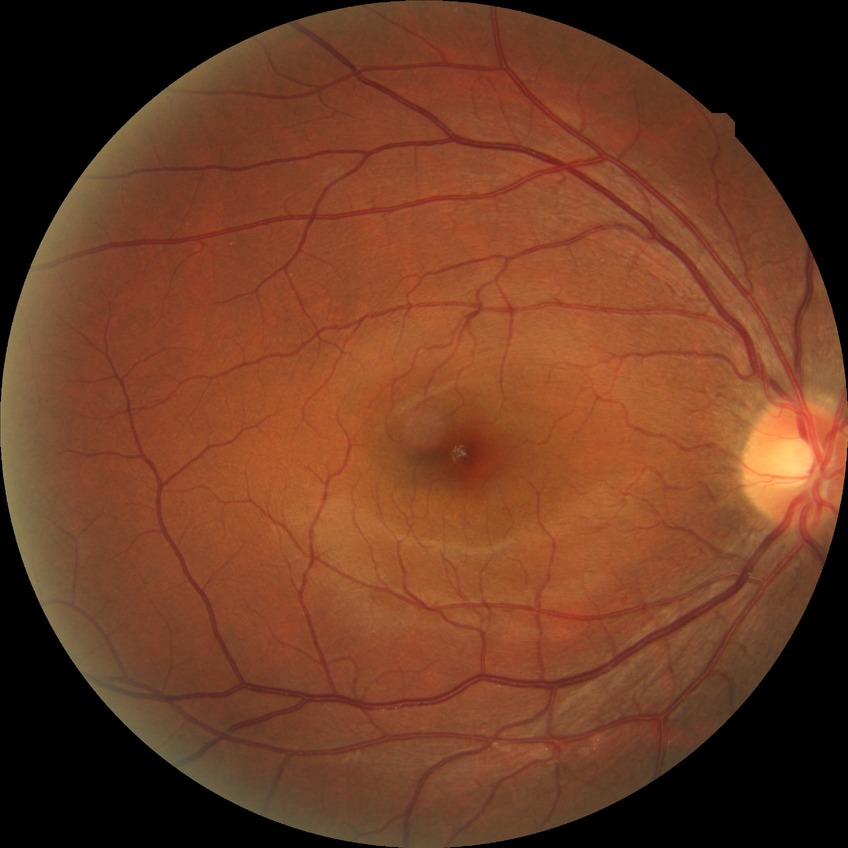

No DR findings. Davis stage is NDR.